Color fundus image. Image size 2352x1568. 45° FOV:
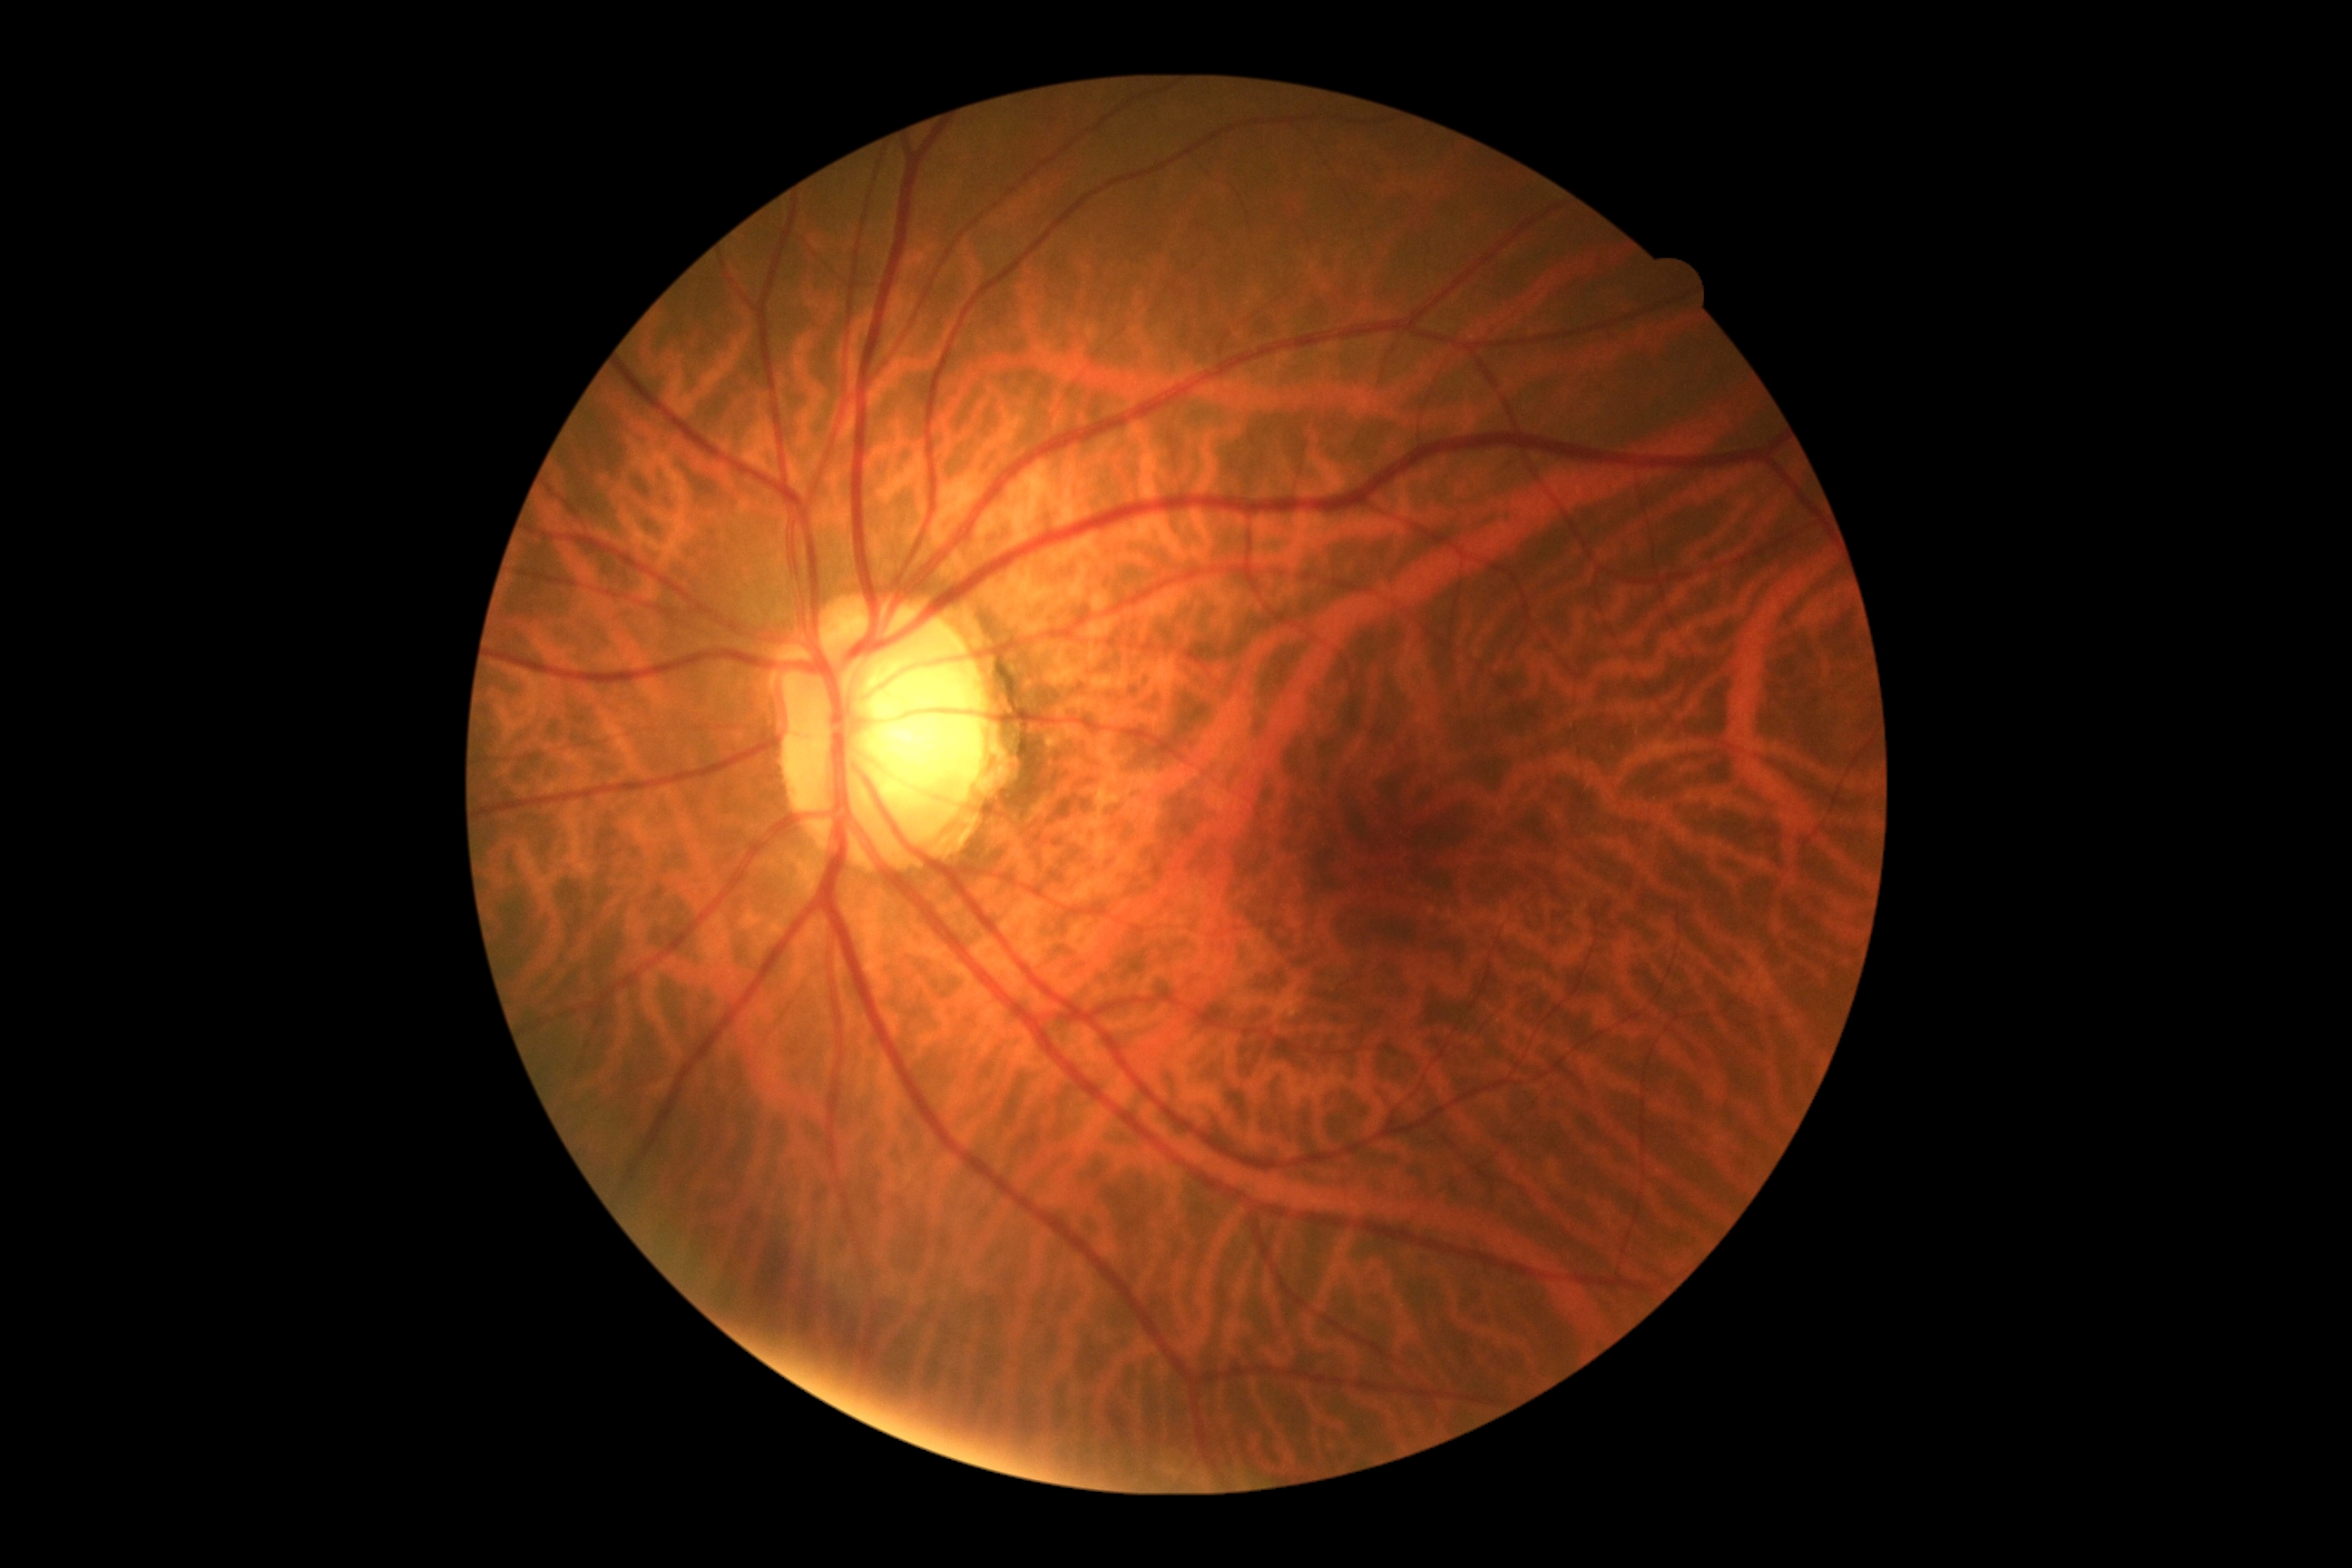
diabetic retinopathy (DR) = 0/4